FOV: 45 degrees
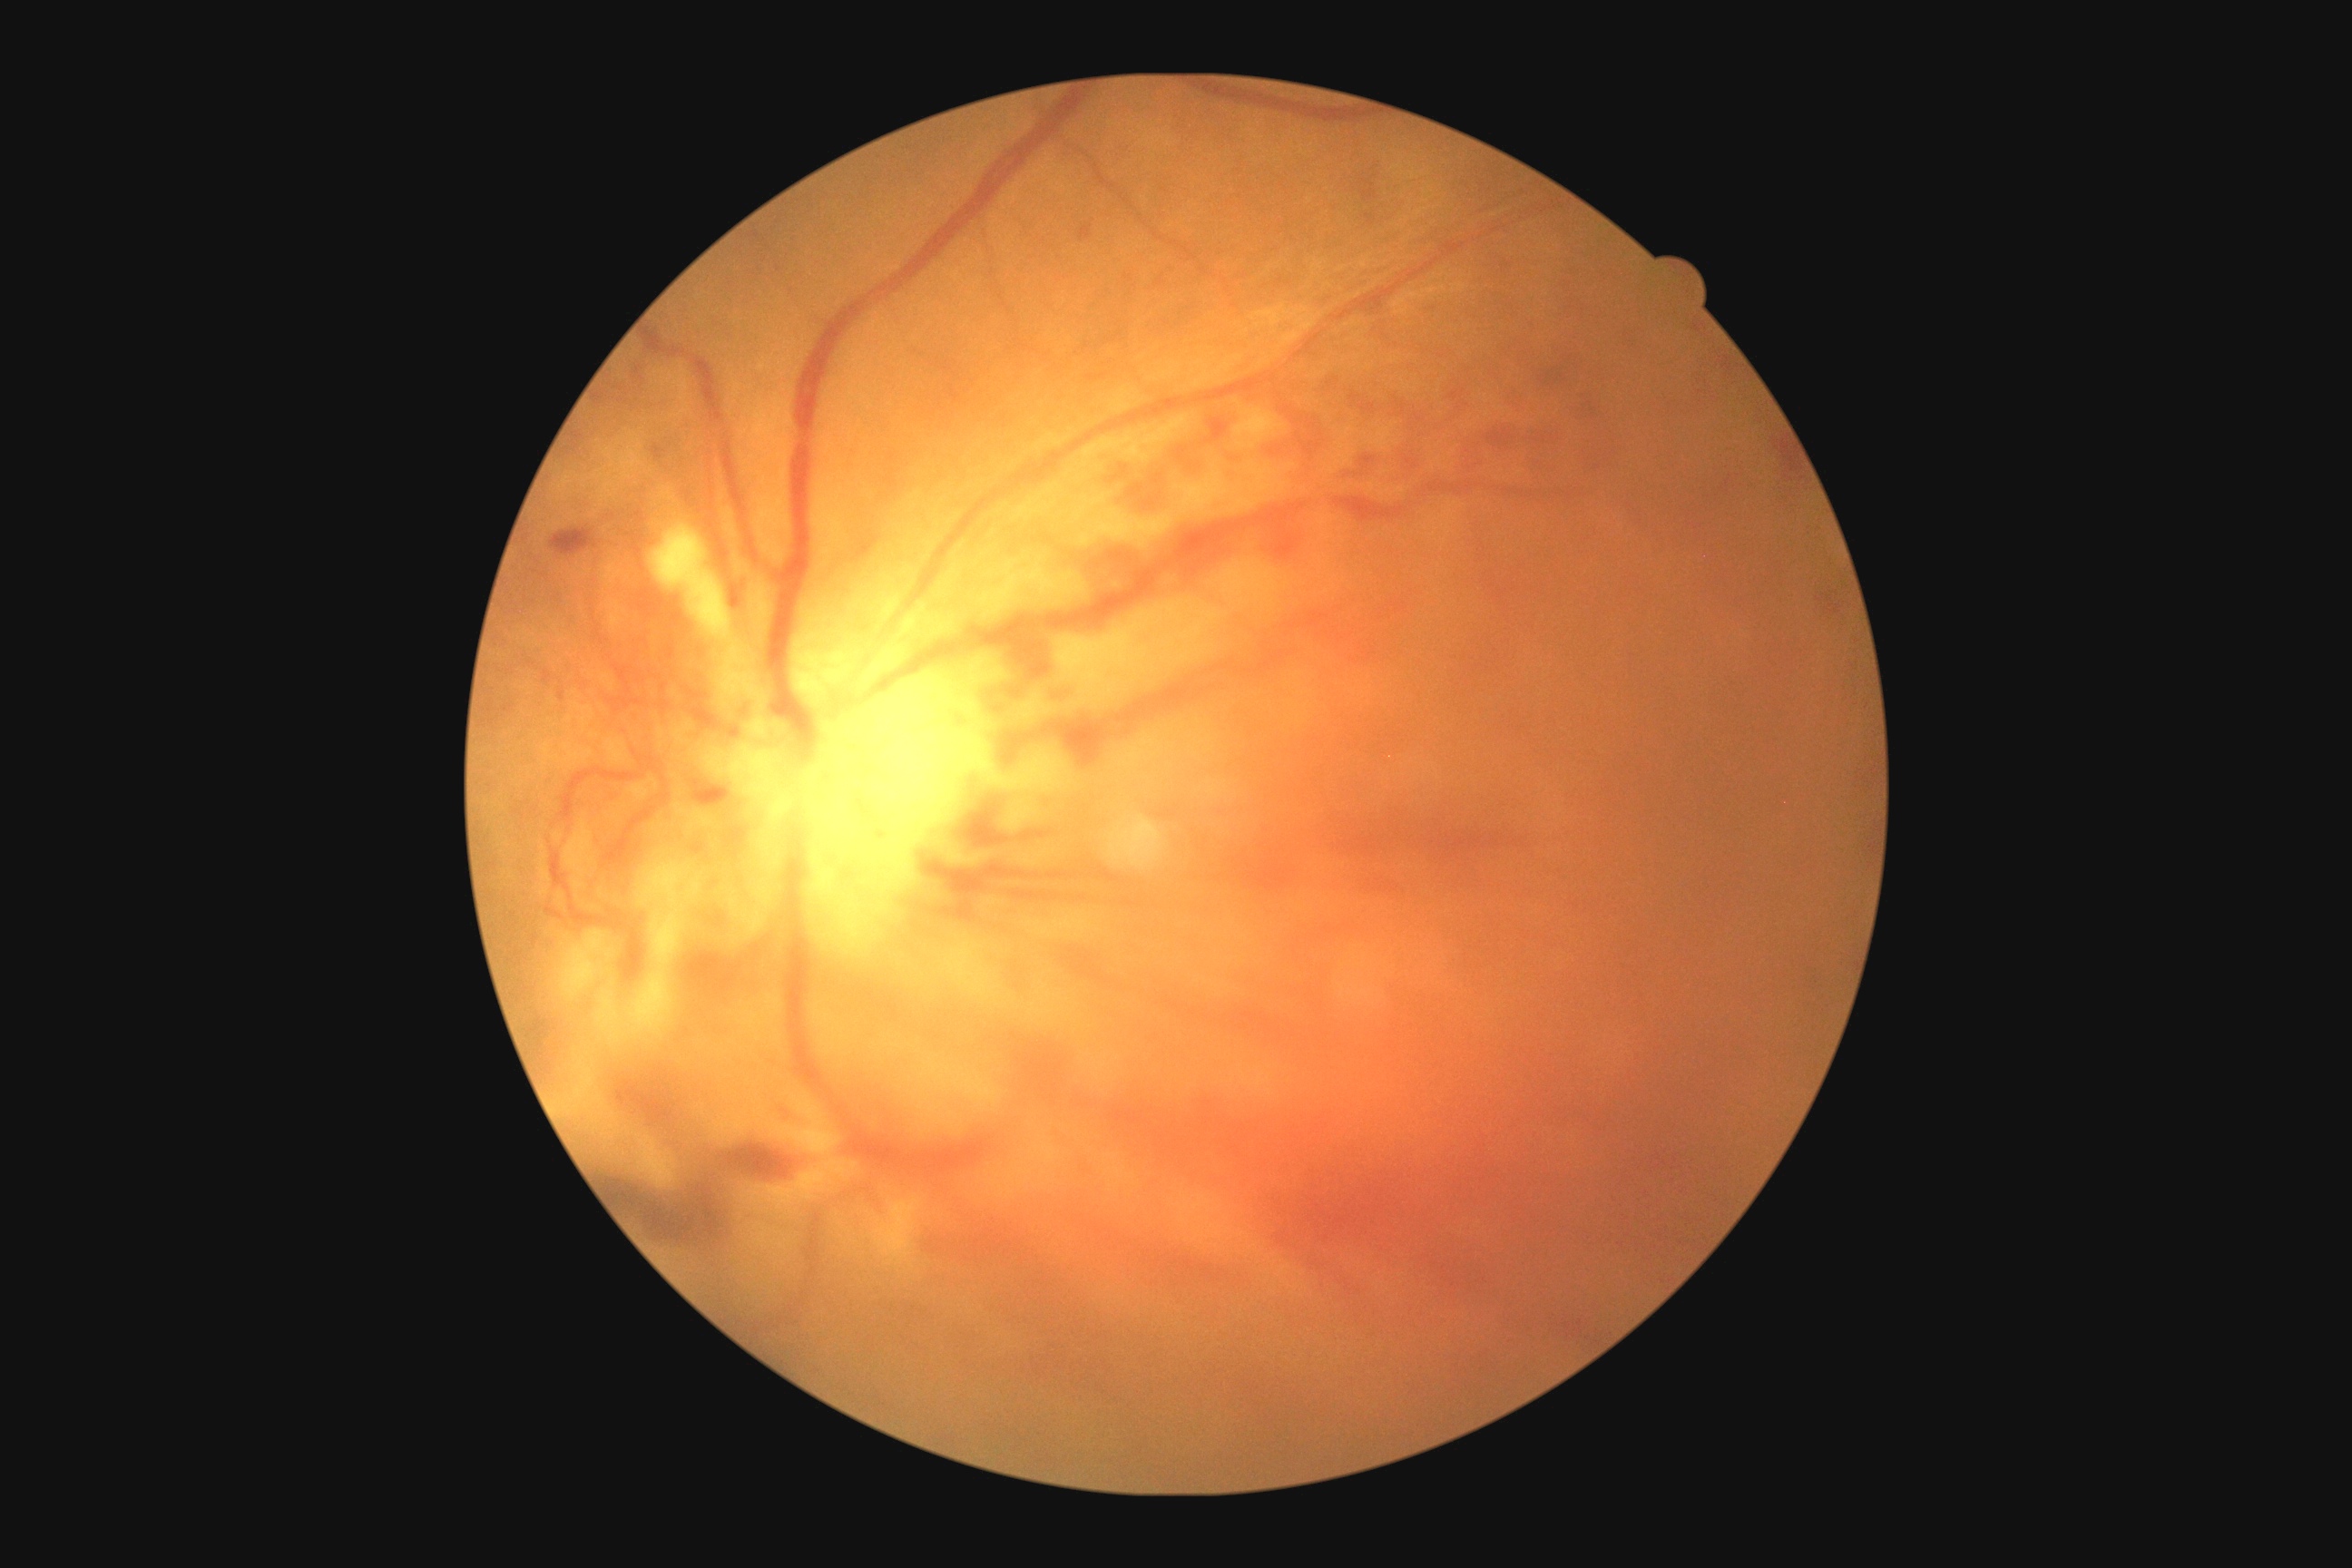
{
  "dr_grade": "PDR (4)"
}